Camera: Remidio smartphone fundus camera — 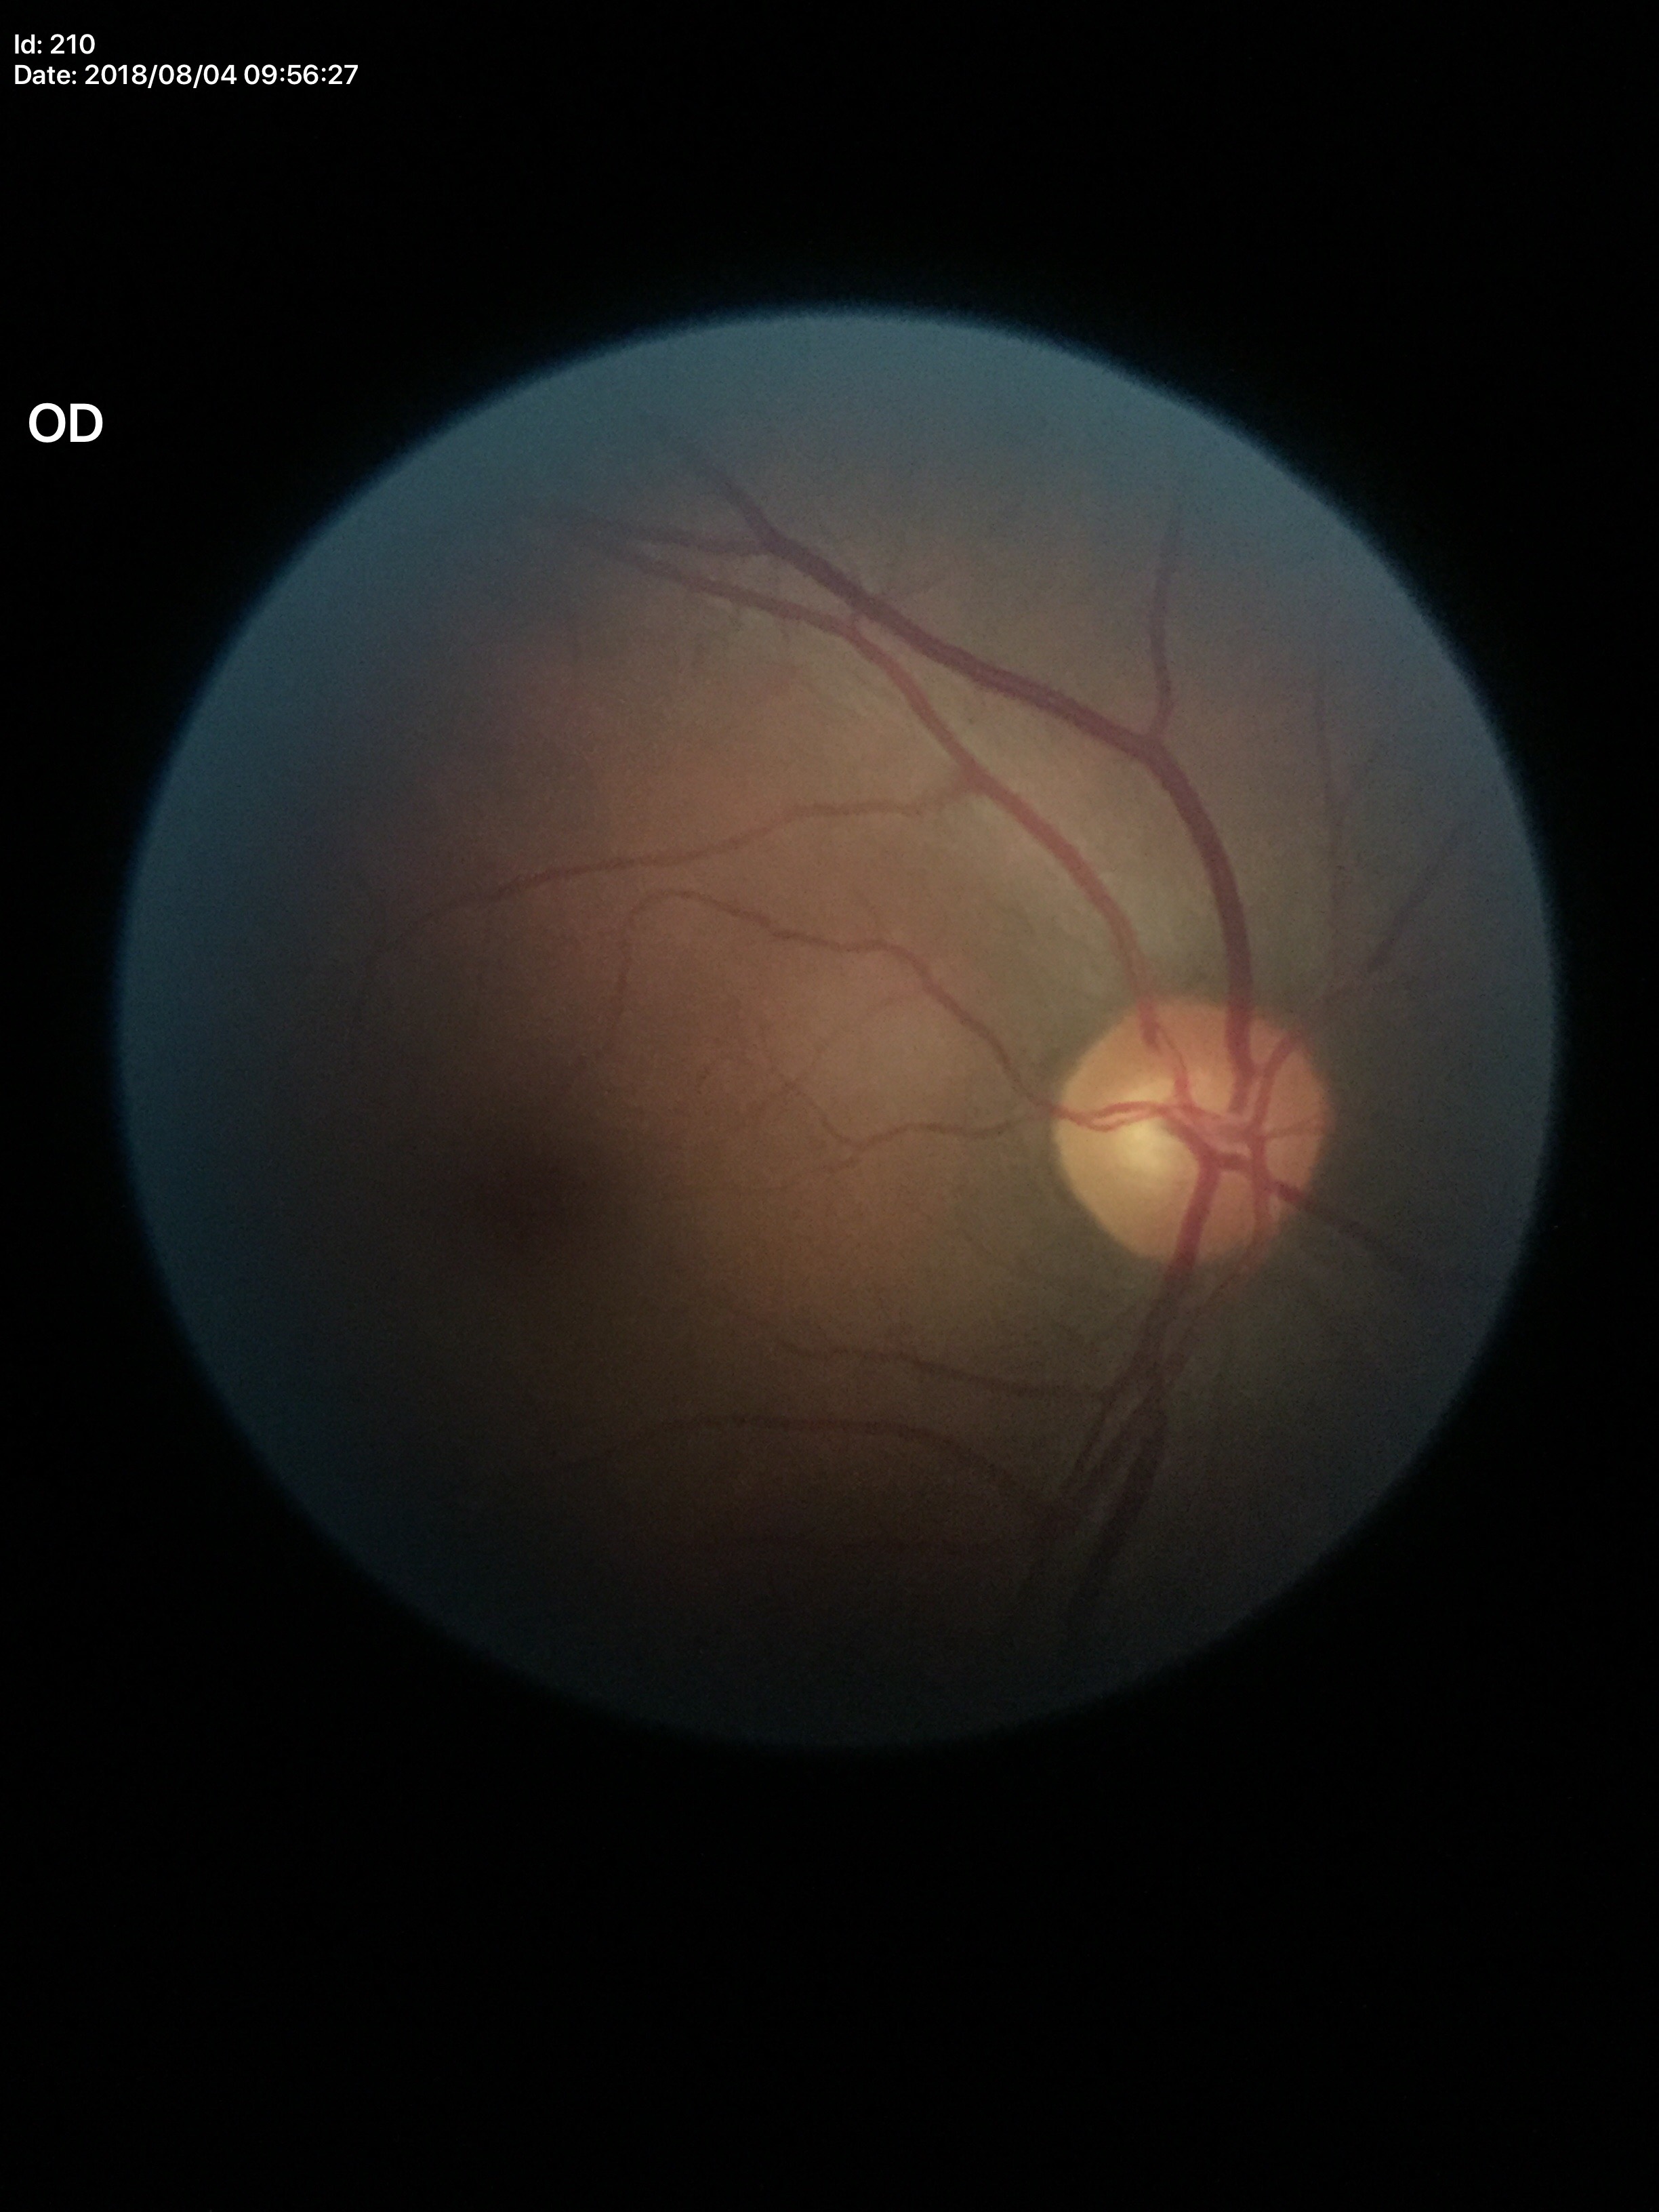 Glaucoma impression: negative.
VCDR is 0.54.